45-degree field of view, 2352 by 1568 pixels: 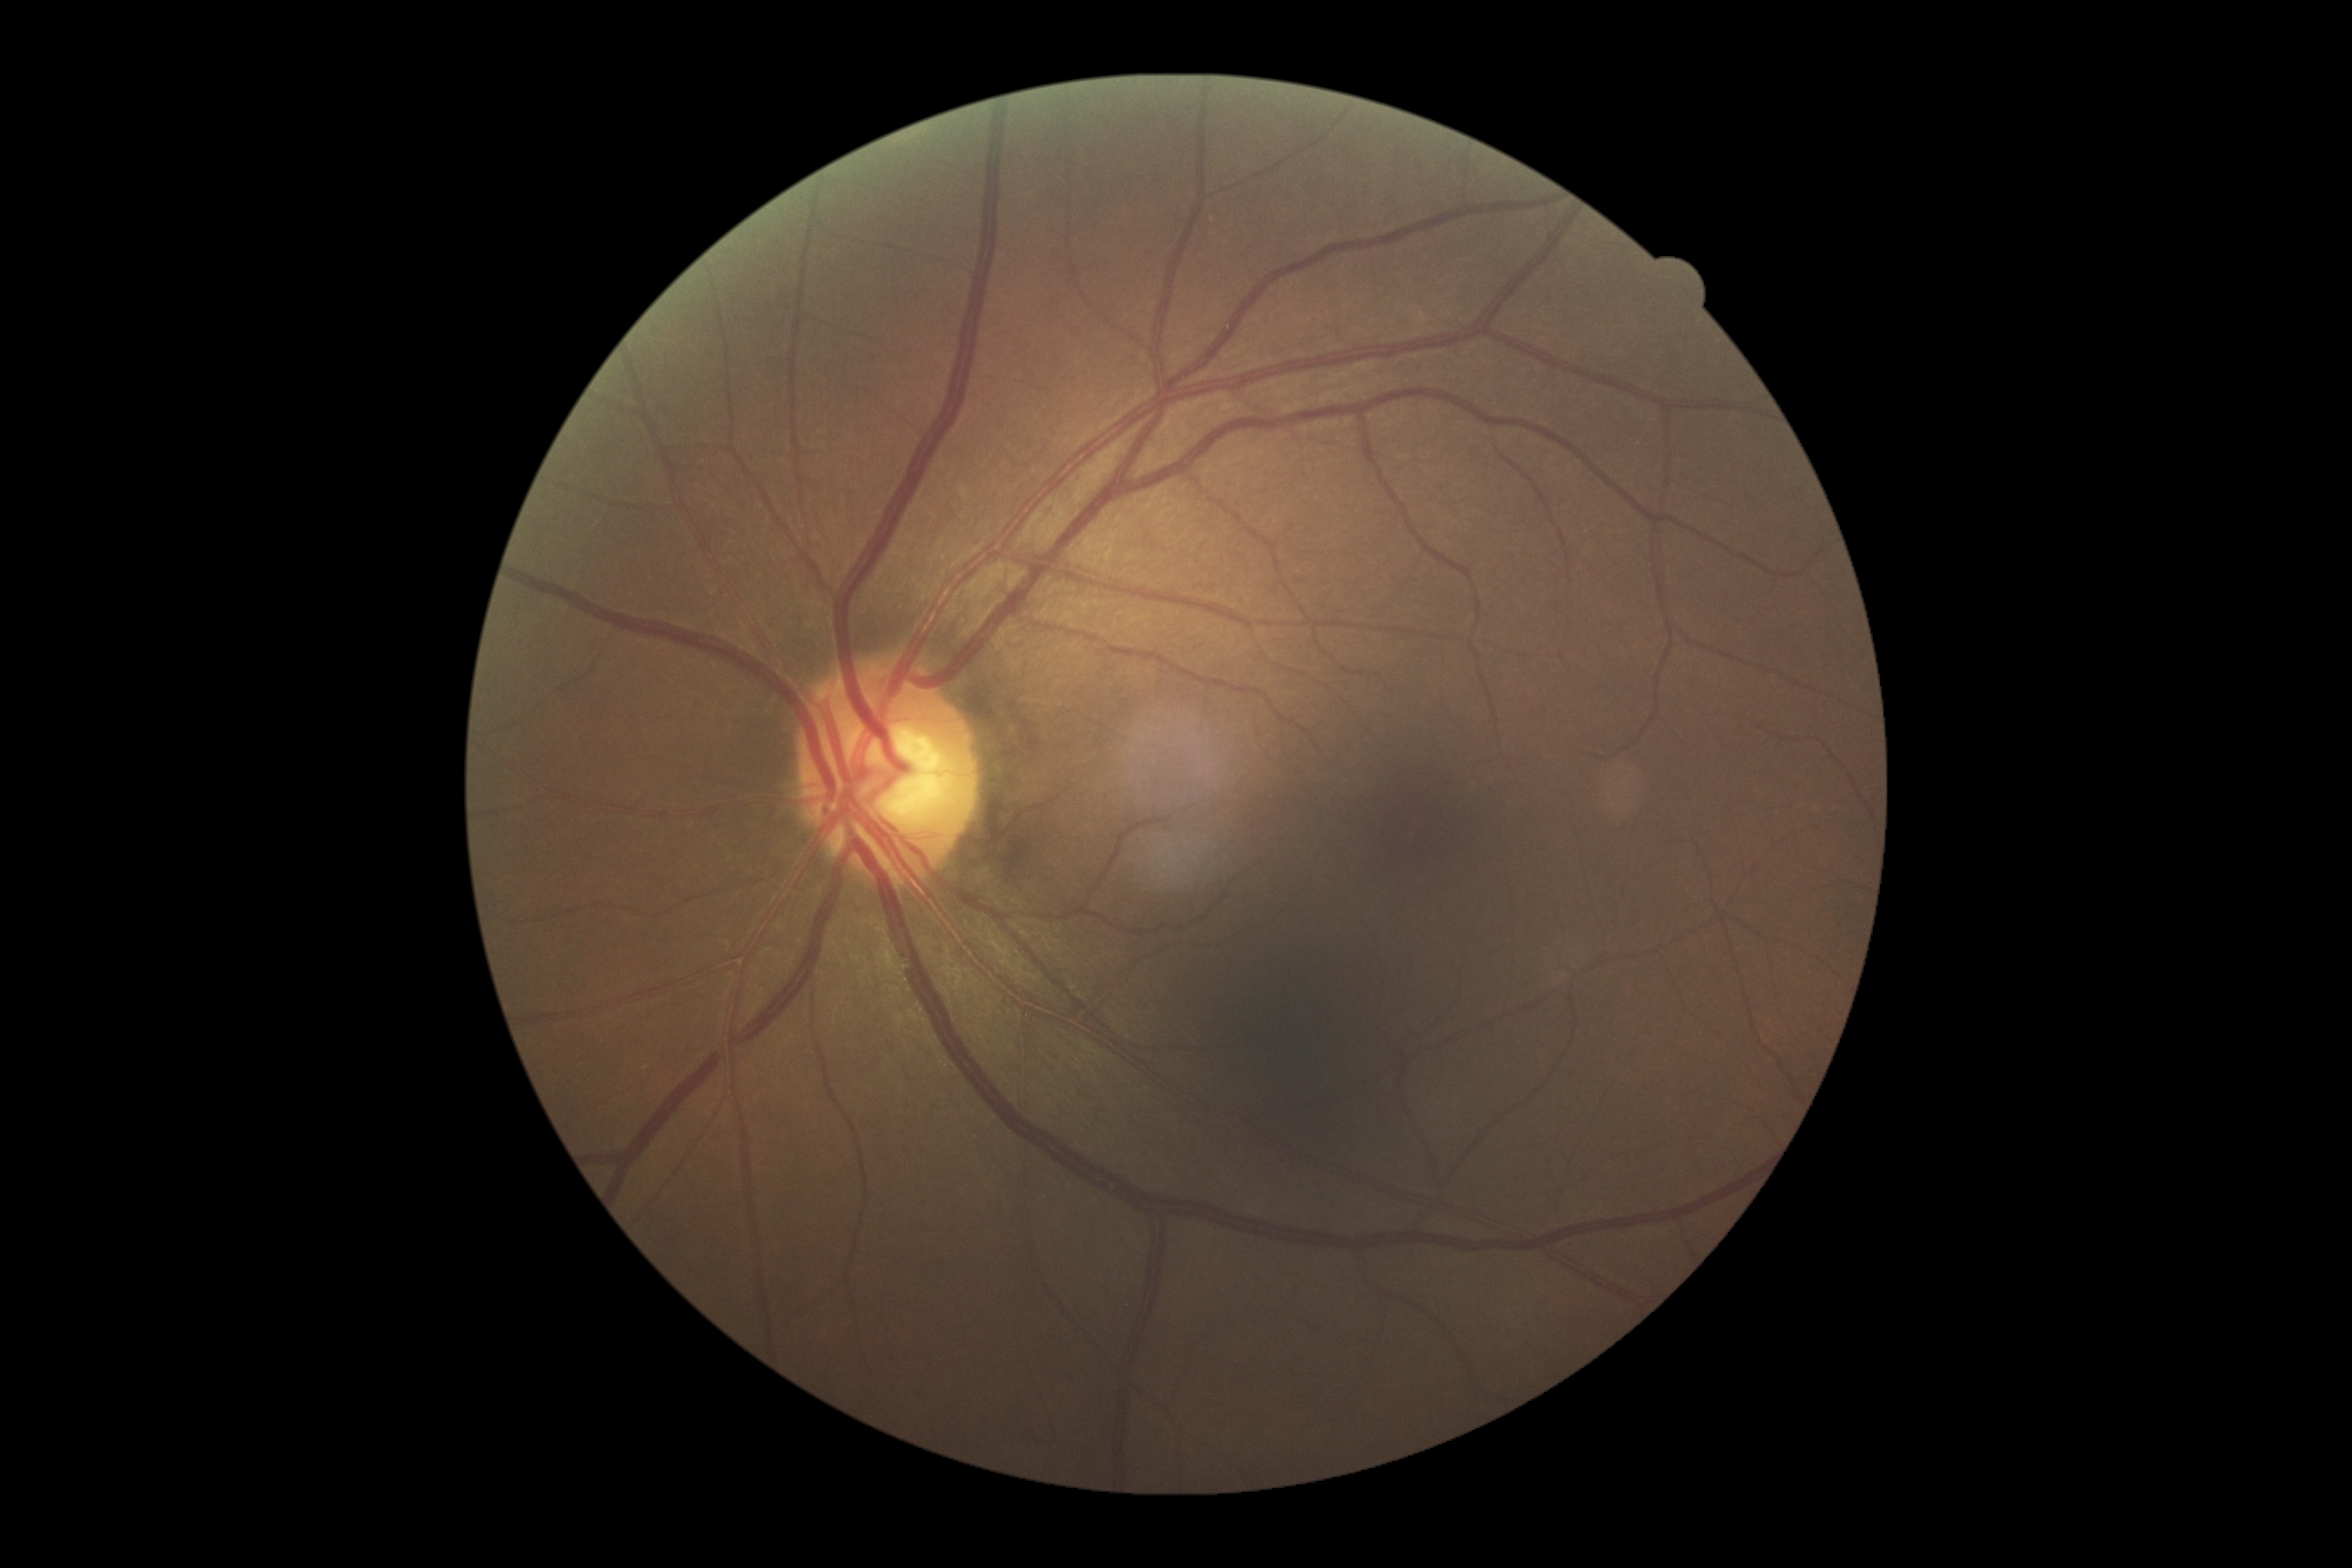

DR: grade 0.